NIDEK AFC-230 fundus camera; nonmydriatic; 848 x 848 pixels: 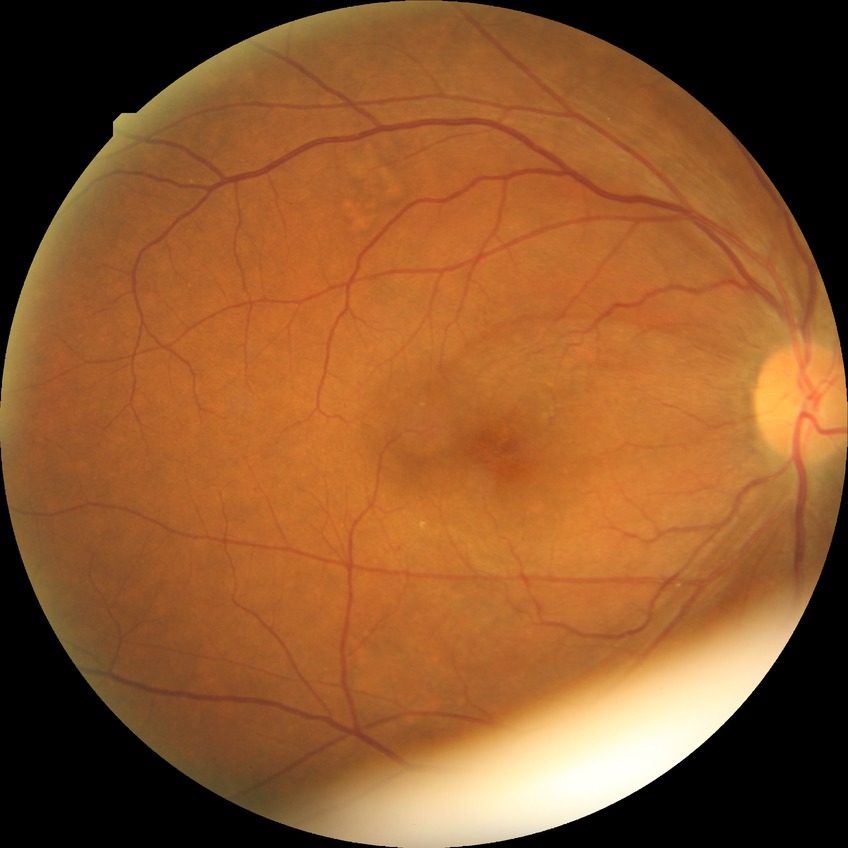
Annotations:
– diabetic retinopathy (DR): NDR (no diabetic retinopathy)